Wide-field fundus image from infant ROP screening
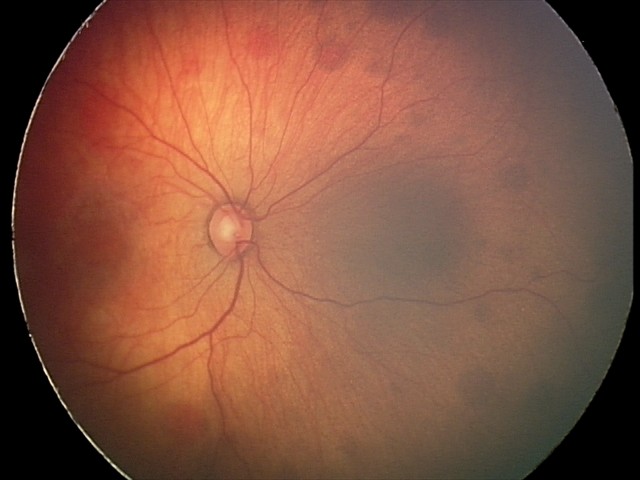

Q: What is the screening diagnosis?
A: retinal hemorrhages